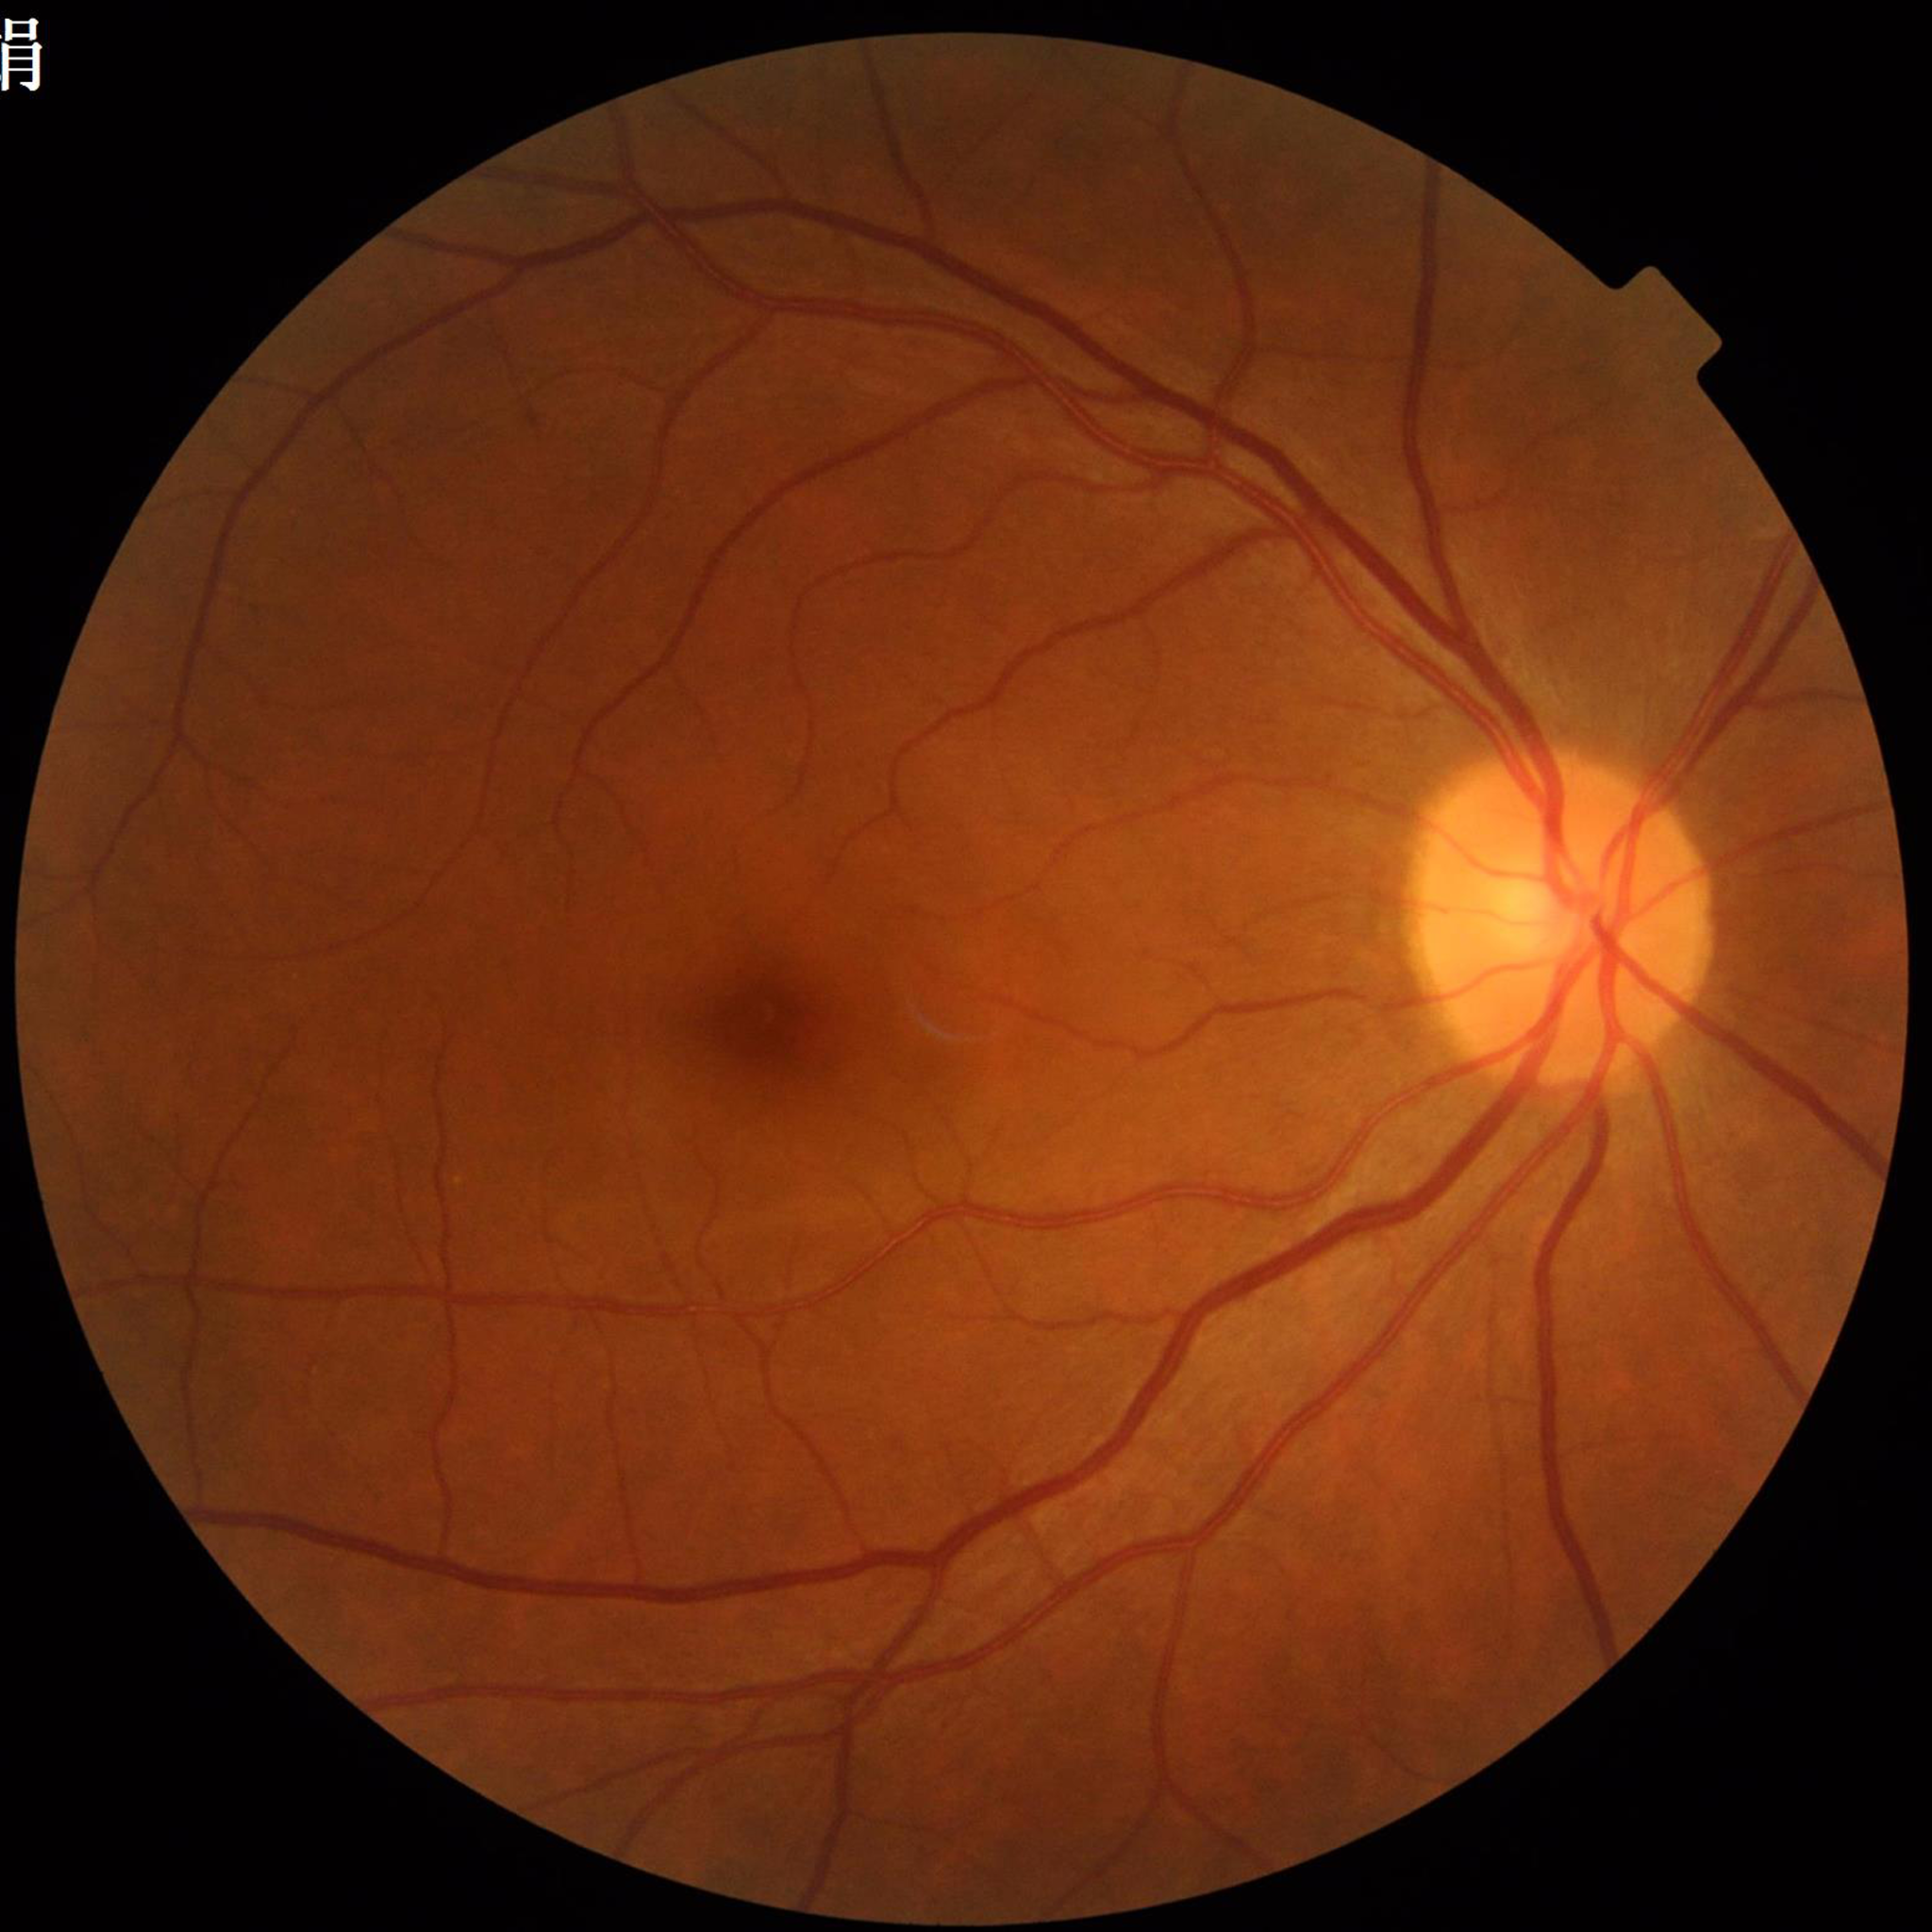
{"diagnosis": "diabetic retinopathy", "image_quality": "adequate"}